Fundus photo.
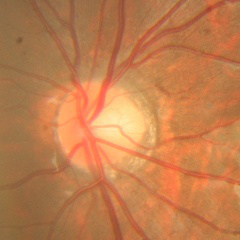
Glaucoma diagnosis = no glaucoma.